Fundus photo
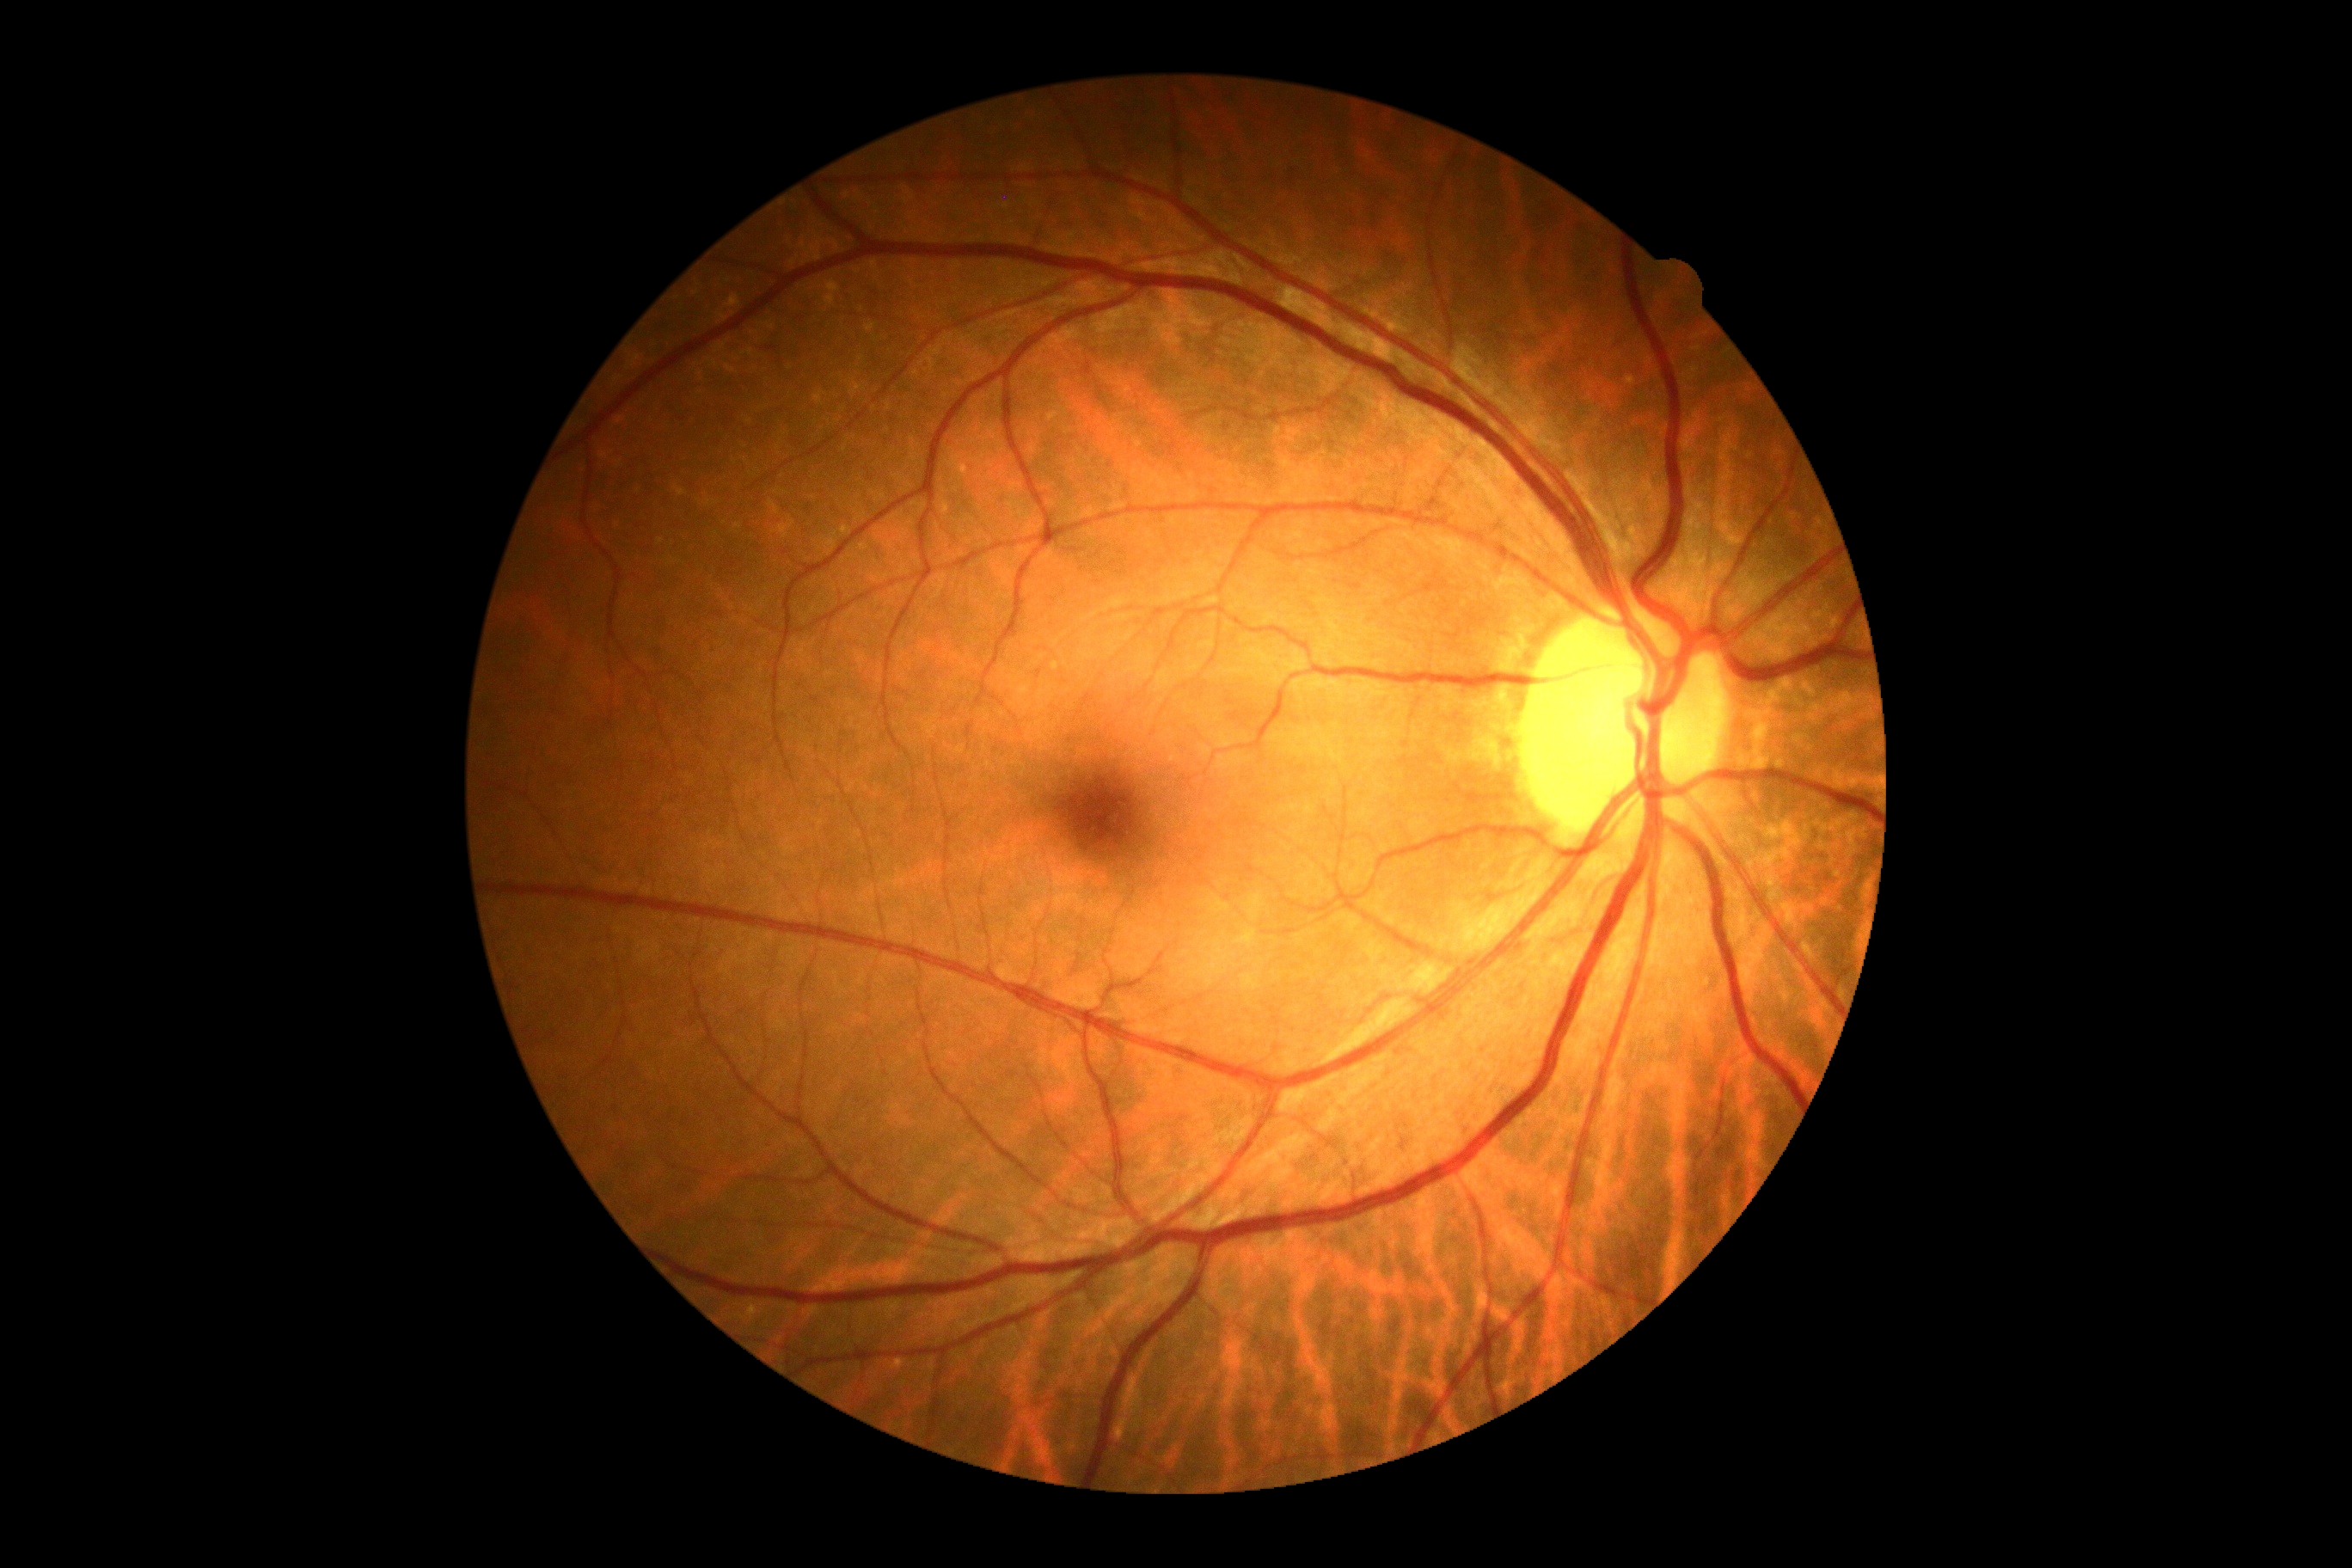 diabetic retinopathy grade: no apparent diabetic retinopathy (0).